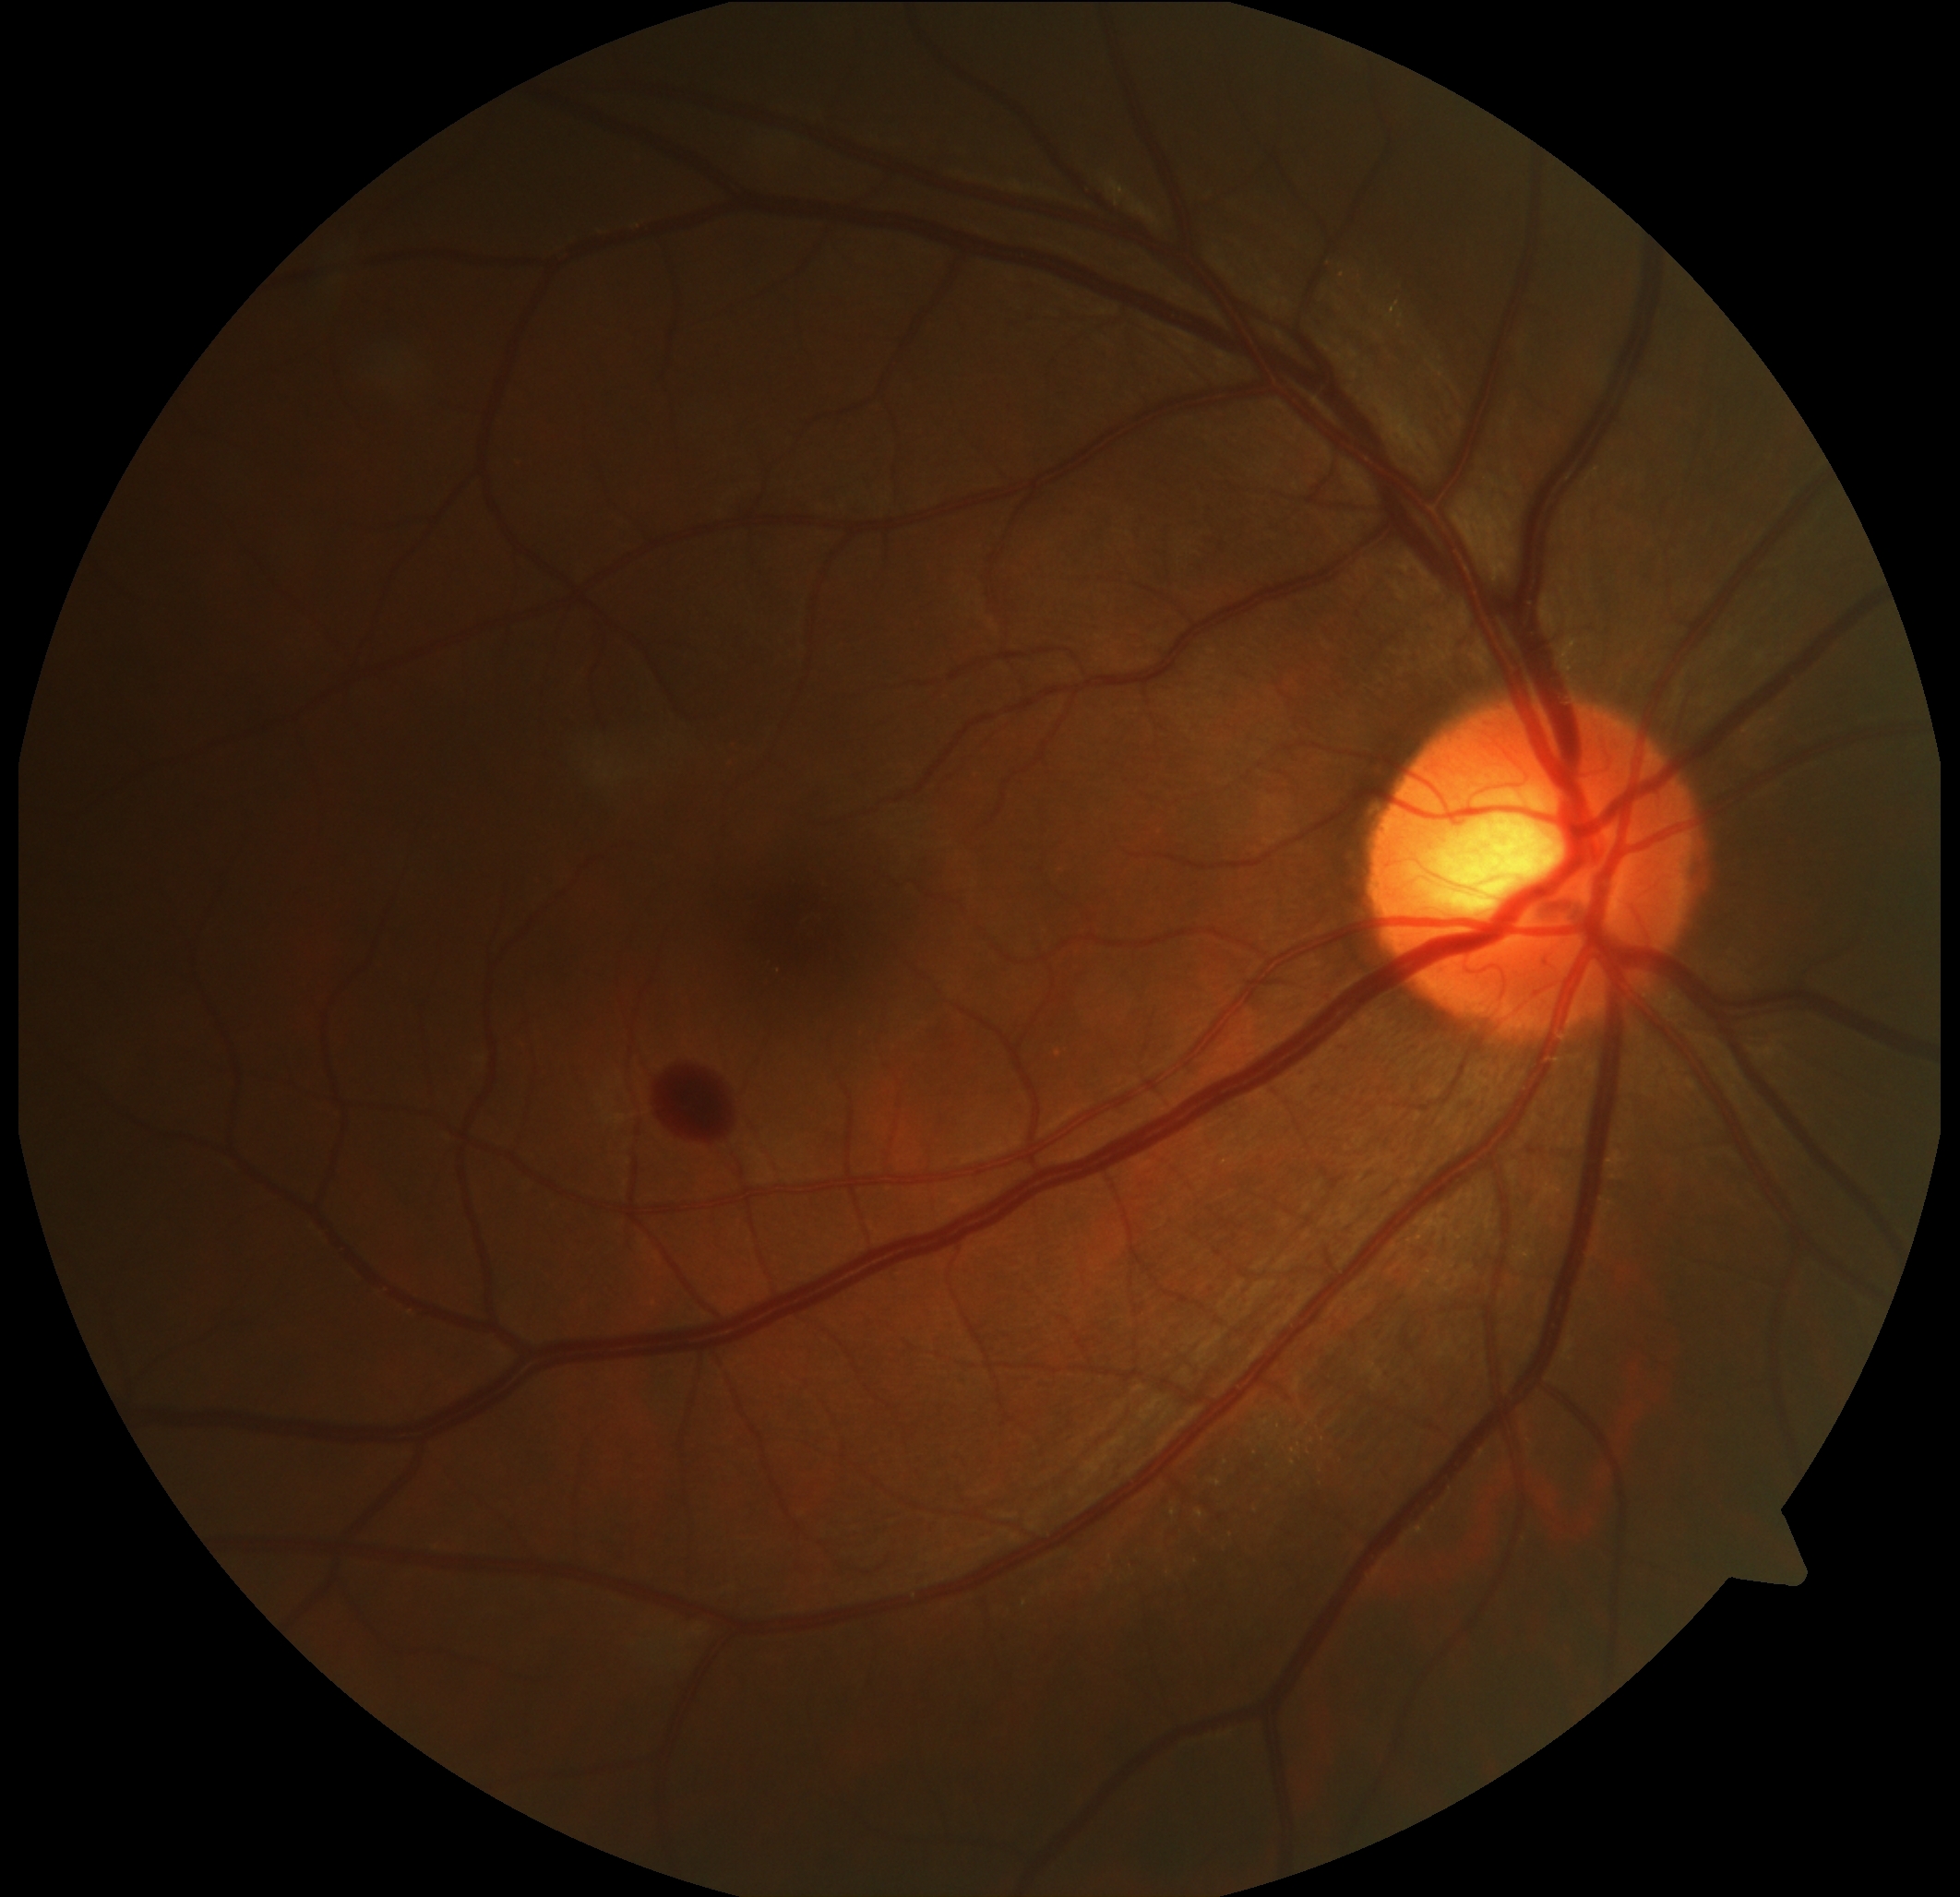
- diabetic retinopathy (DR) — 2